Diabetic retinopathy graded by the modified Davis classification: 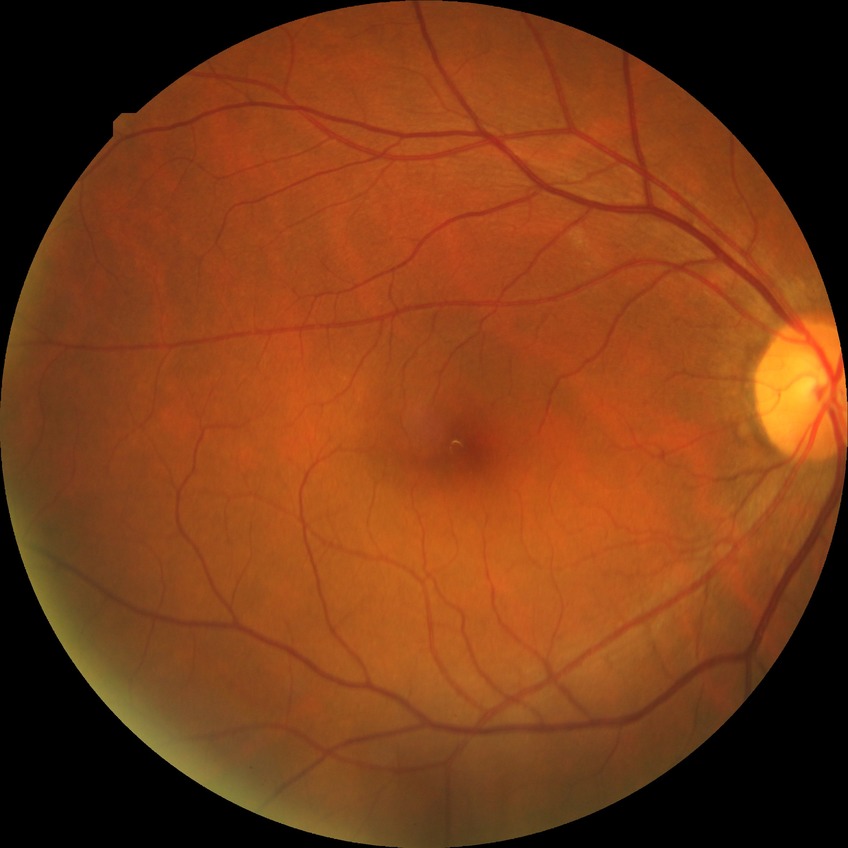 diabetic retinopathy (DR)@no diabetic retinopathy (NDR).